1932x1932: 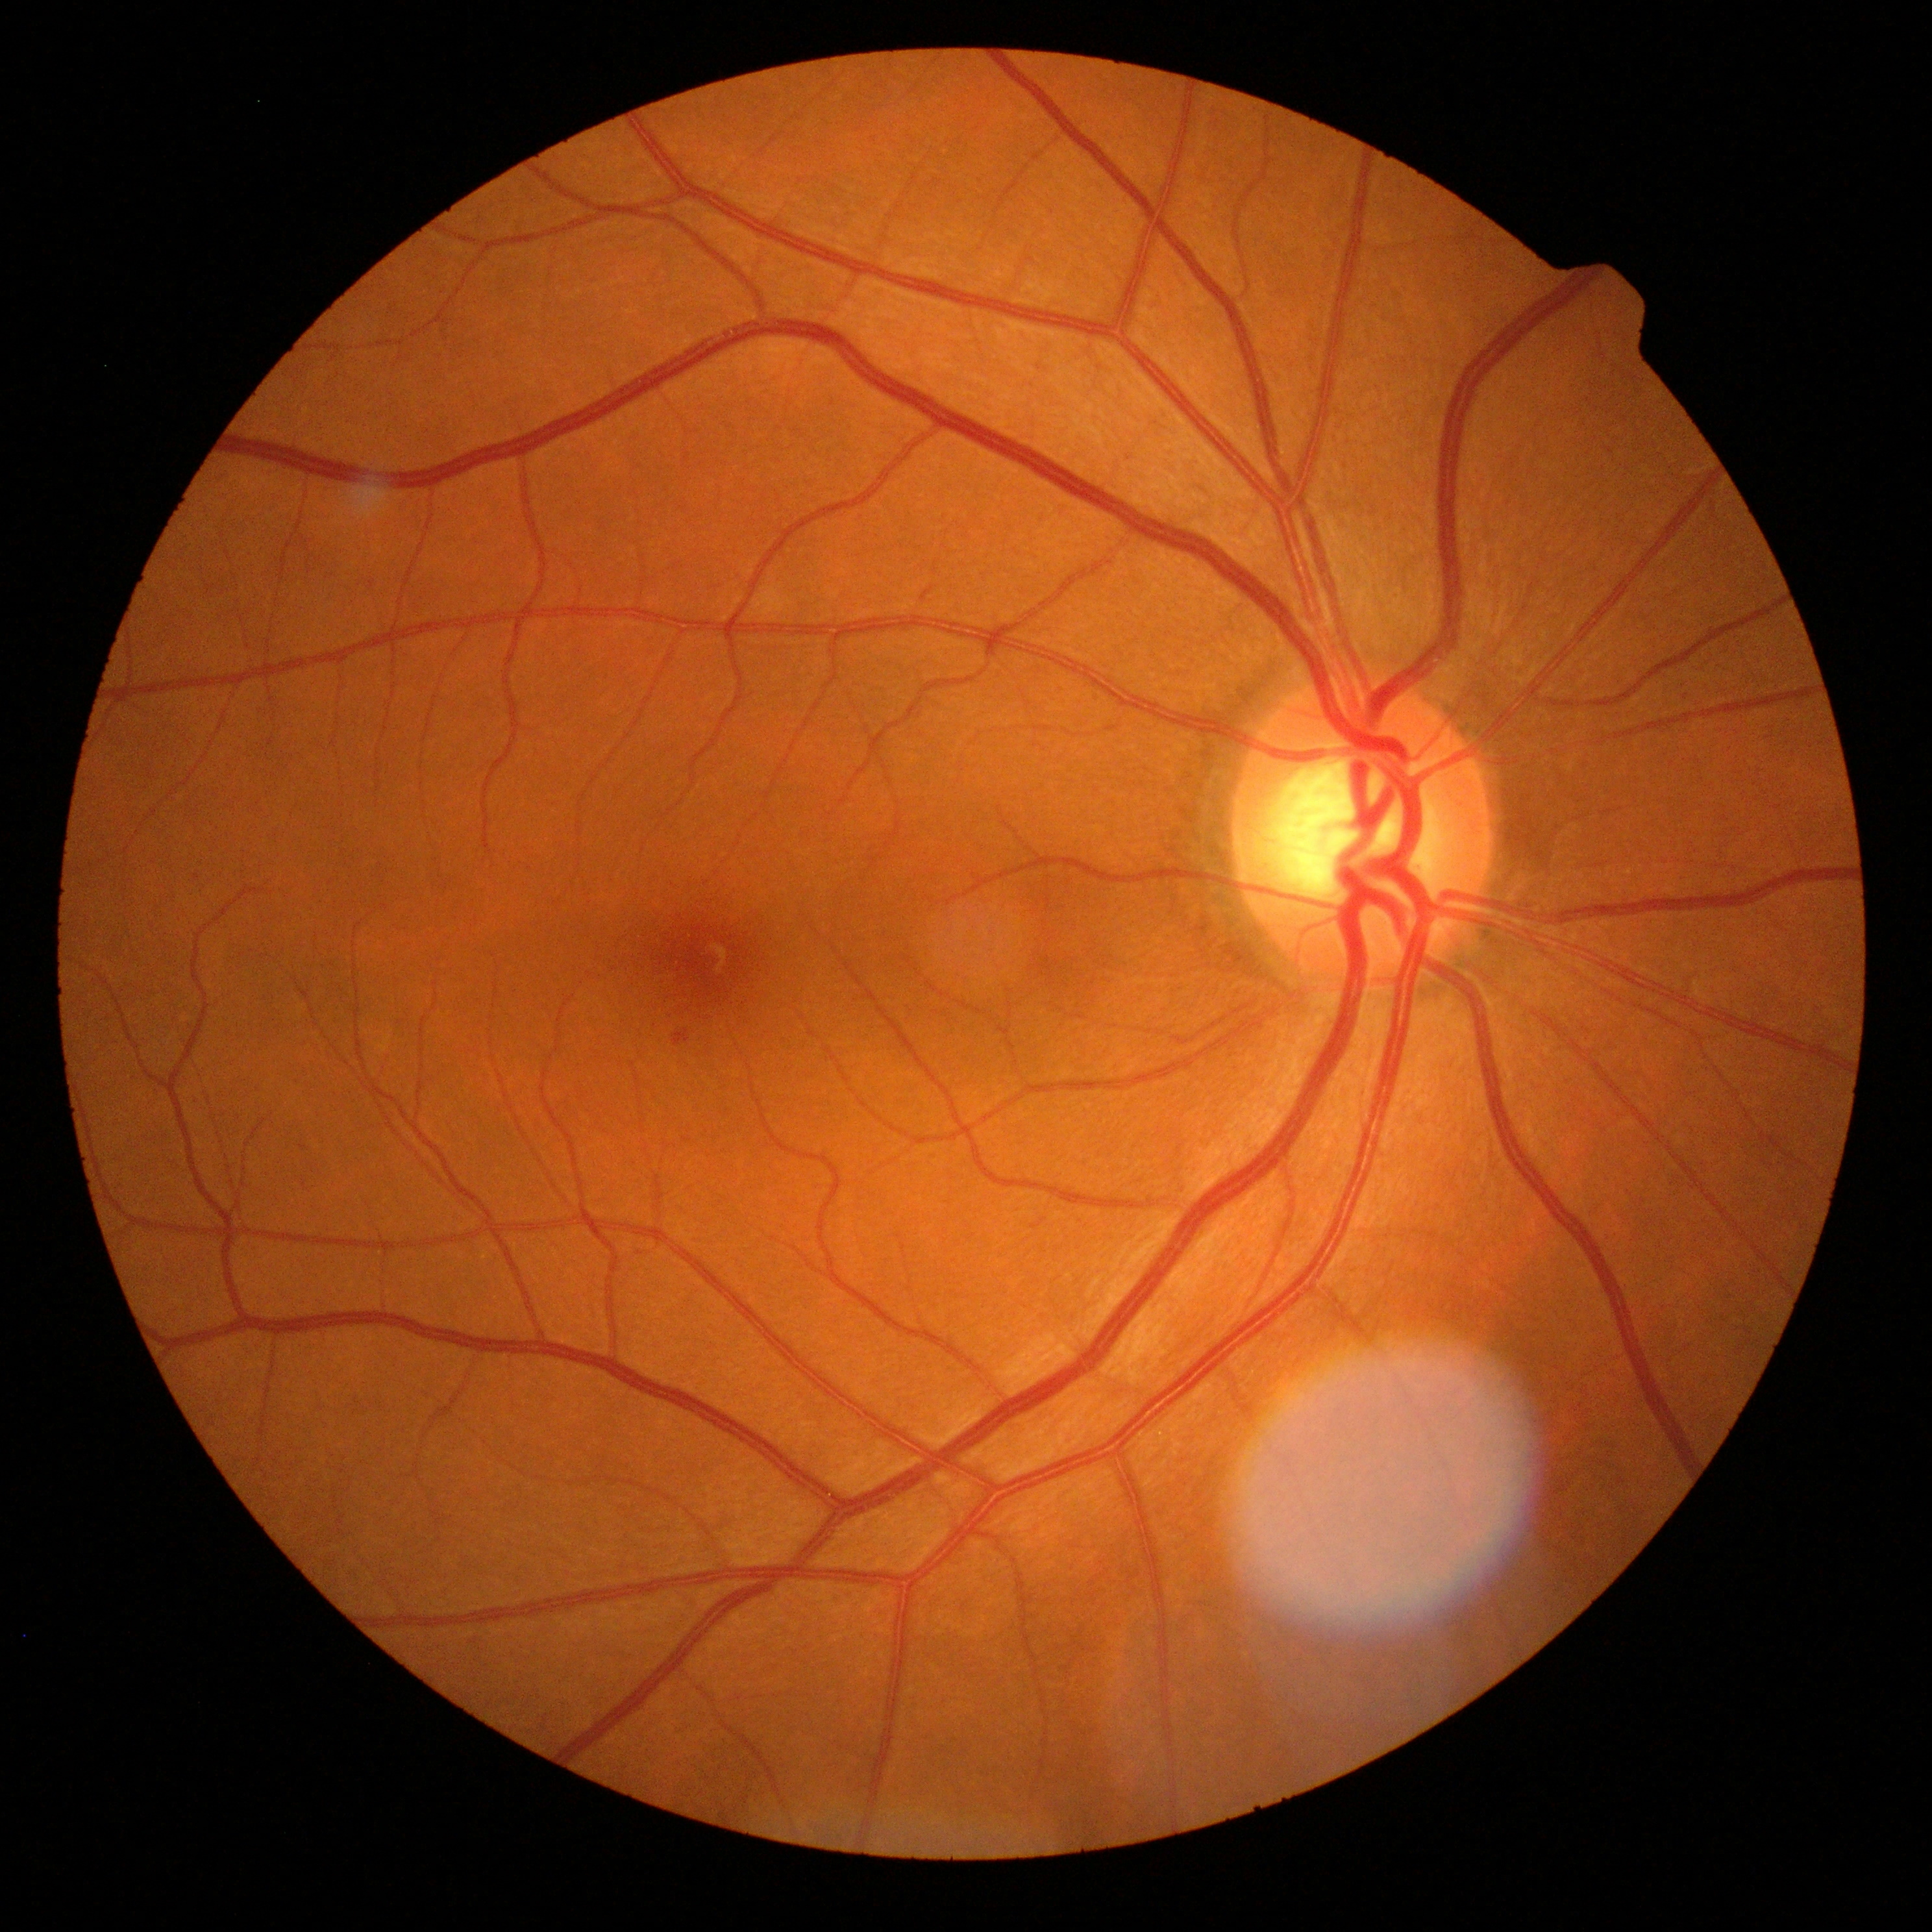 DR grade: 1 (mild NPDR).